45° field of view · color fundus image: 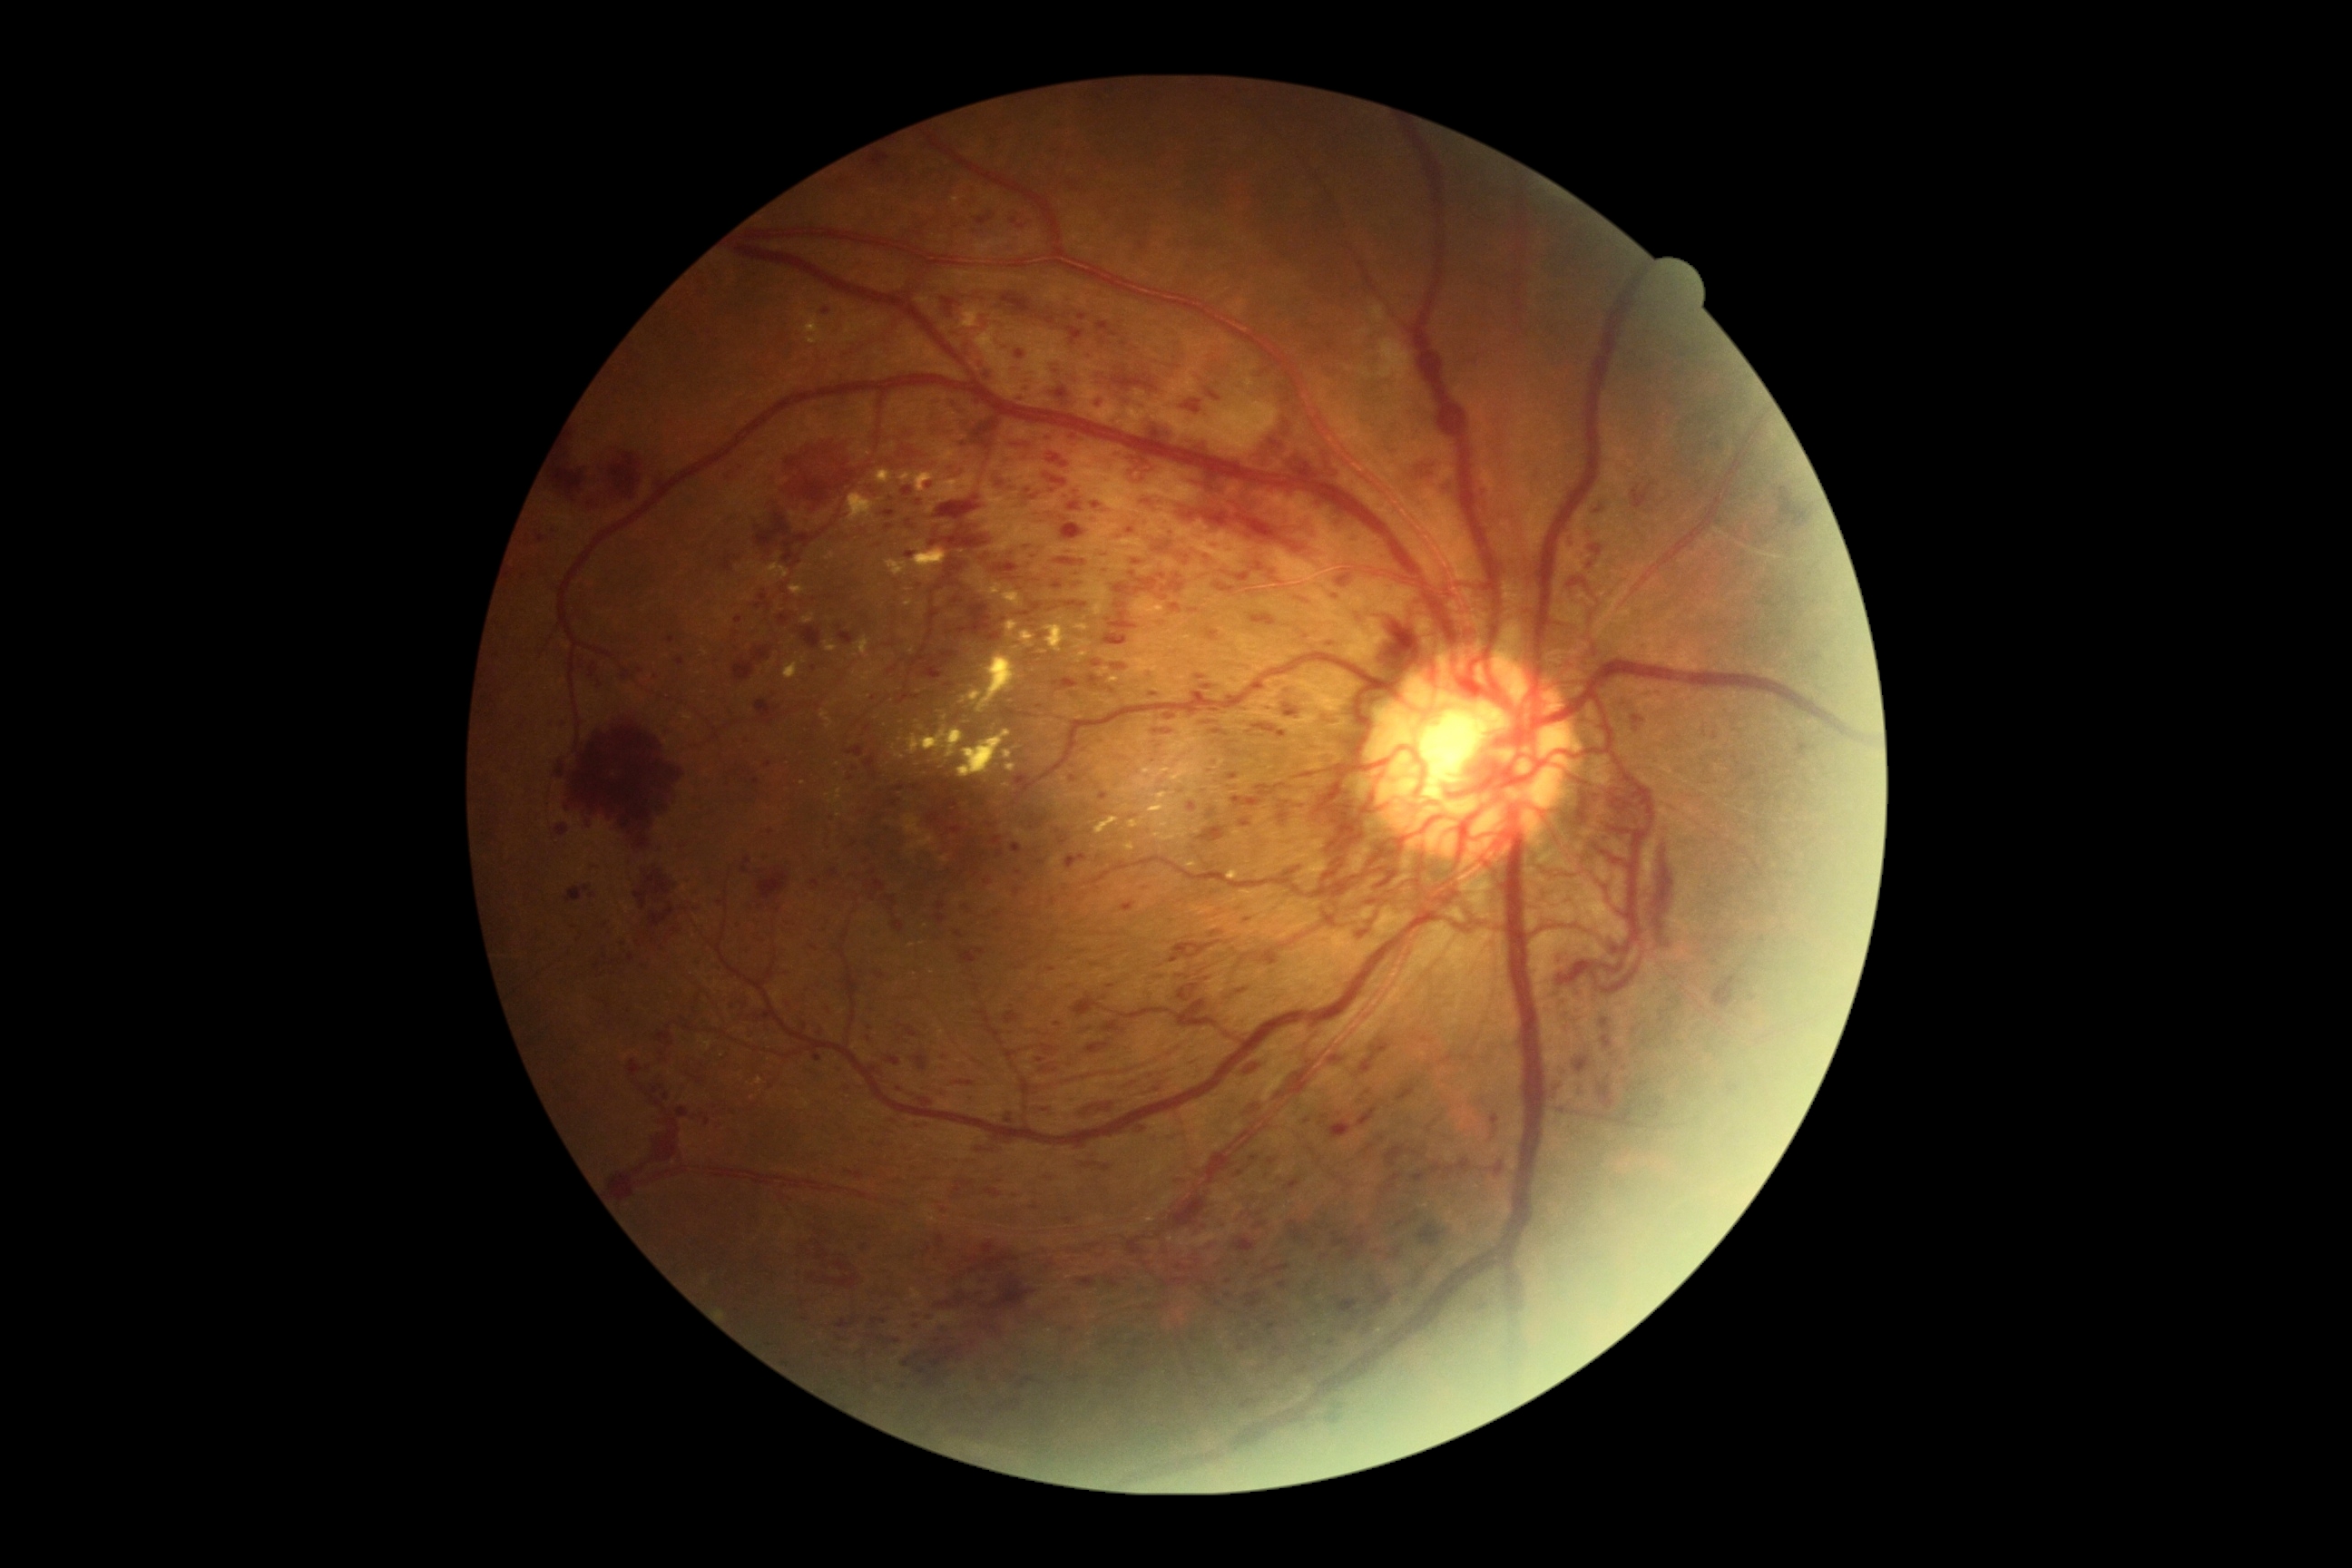
Diabetic retinopathy (DR) is 4/4 — neovascularization and/or vitreous/pre-retinal hemorrhage
A subset of detected lesions:
hemorrhages (HEs) (partial): <bbox>1651, 845, 1674, 948</bbox>; <bbox>1202, 721, 1215, 725</bbox>; <bbox>1215, 583, 1235, 594</bbox>; <bbox>1253, 723, 1288, 740</bbox>; <bbox>1188, 469, 1228, 491</bbox>; <bbox>1030, 1204, 1041, 1211</bbox>; <bbox>1086, 1043, 1110, 1055</bbox>; <bbox>1587, 560, 1596, 571</bbox>; <bbox>1313, 1224, 1322, 1231</bbox>; <bbox>756, 514, 790, 554</bbox>; <bbox>936, 1235, 946, 1250</bbox>; <bbox>959, 948, 986, 965</bbox>; <bbox>1567, 578, 1592, 593</bbox>; <bbox>1796, 745, 1810, 758</bbox>; <bbox>1574, 1057, 1591, 1073</bbox>; <bbox>1600, 1019, 1611, 1030</bbox>
Additional small HEs near pt(1361, 1229); pt(1302, 806); pt(1076, 586)